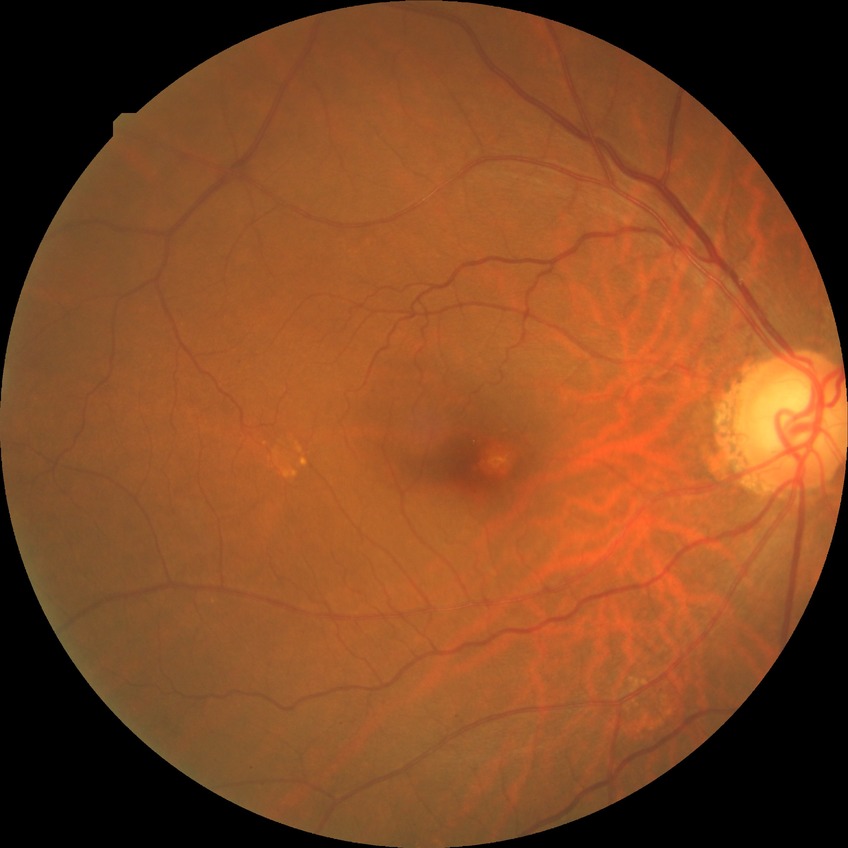
Diabetic retinopathy (DR): NDR (no diabetic retinopathy).